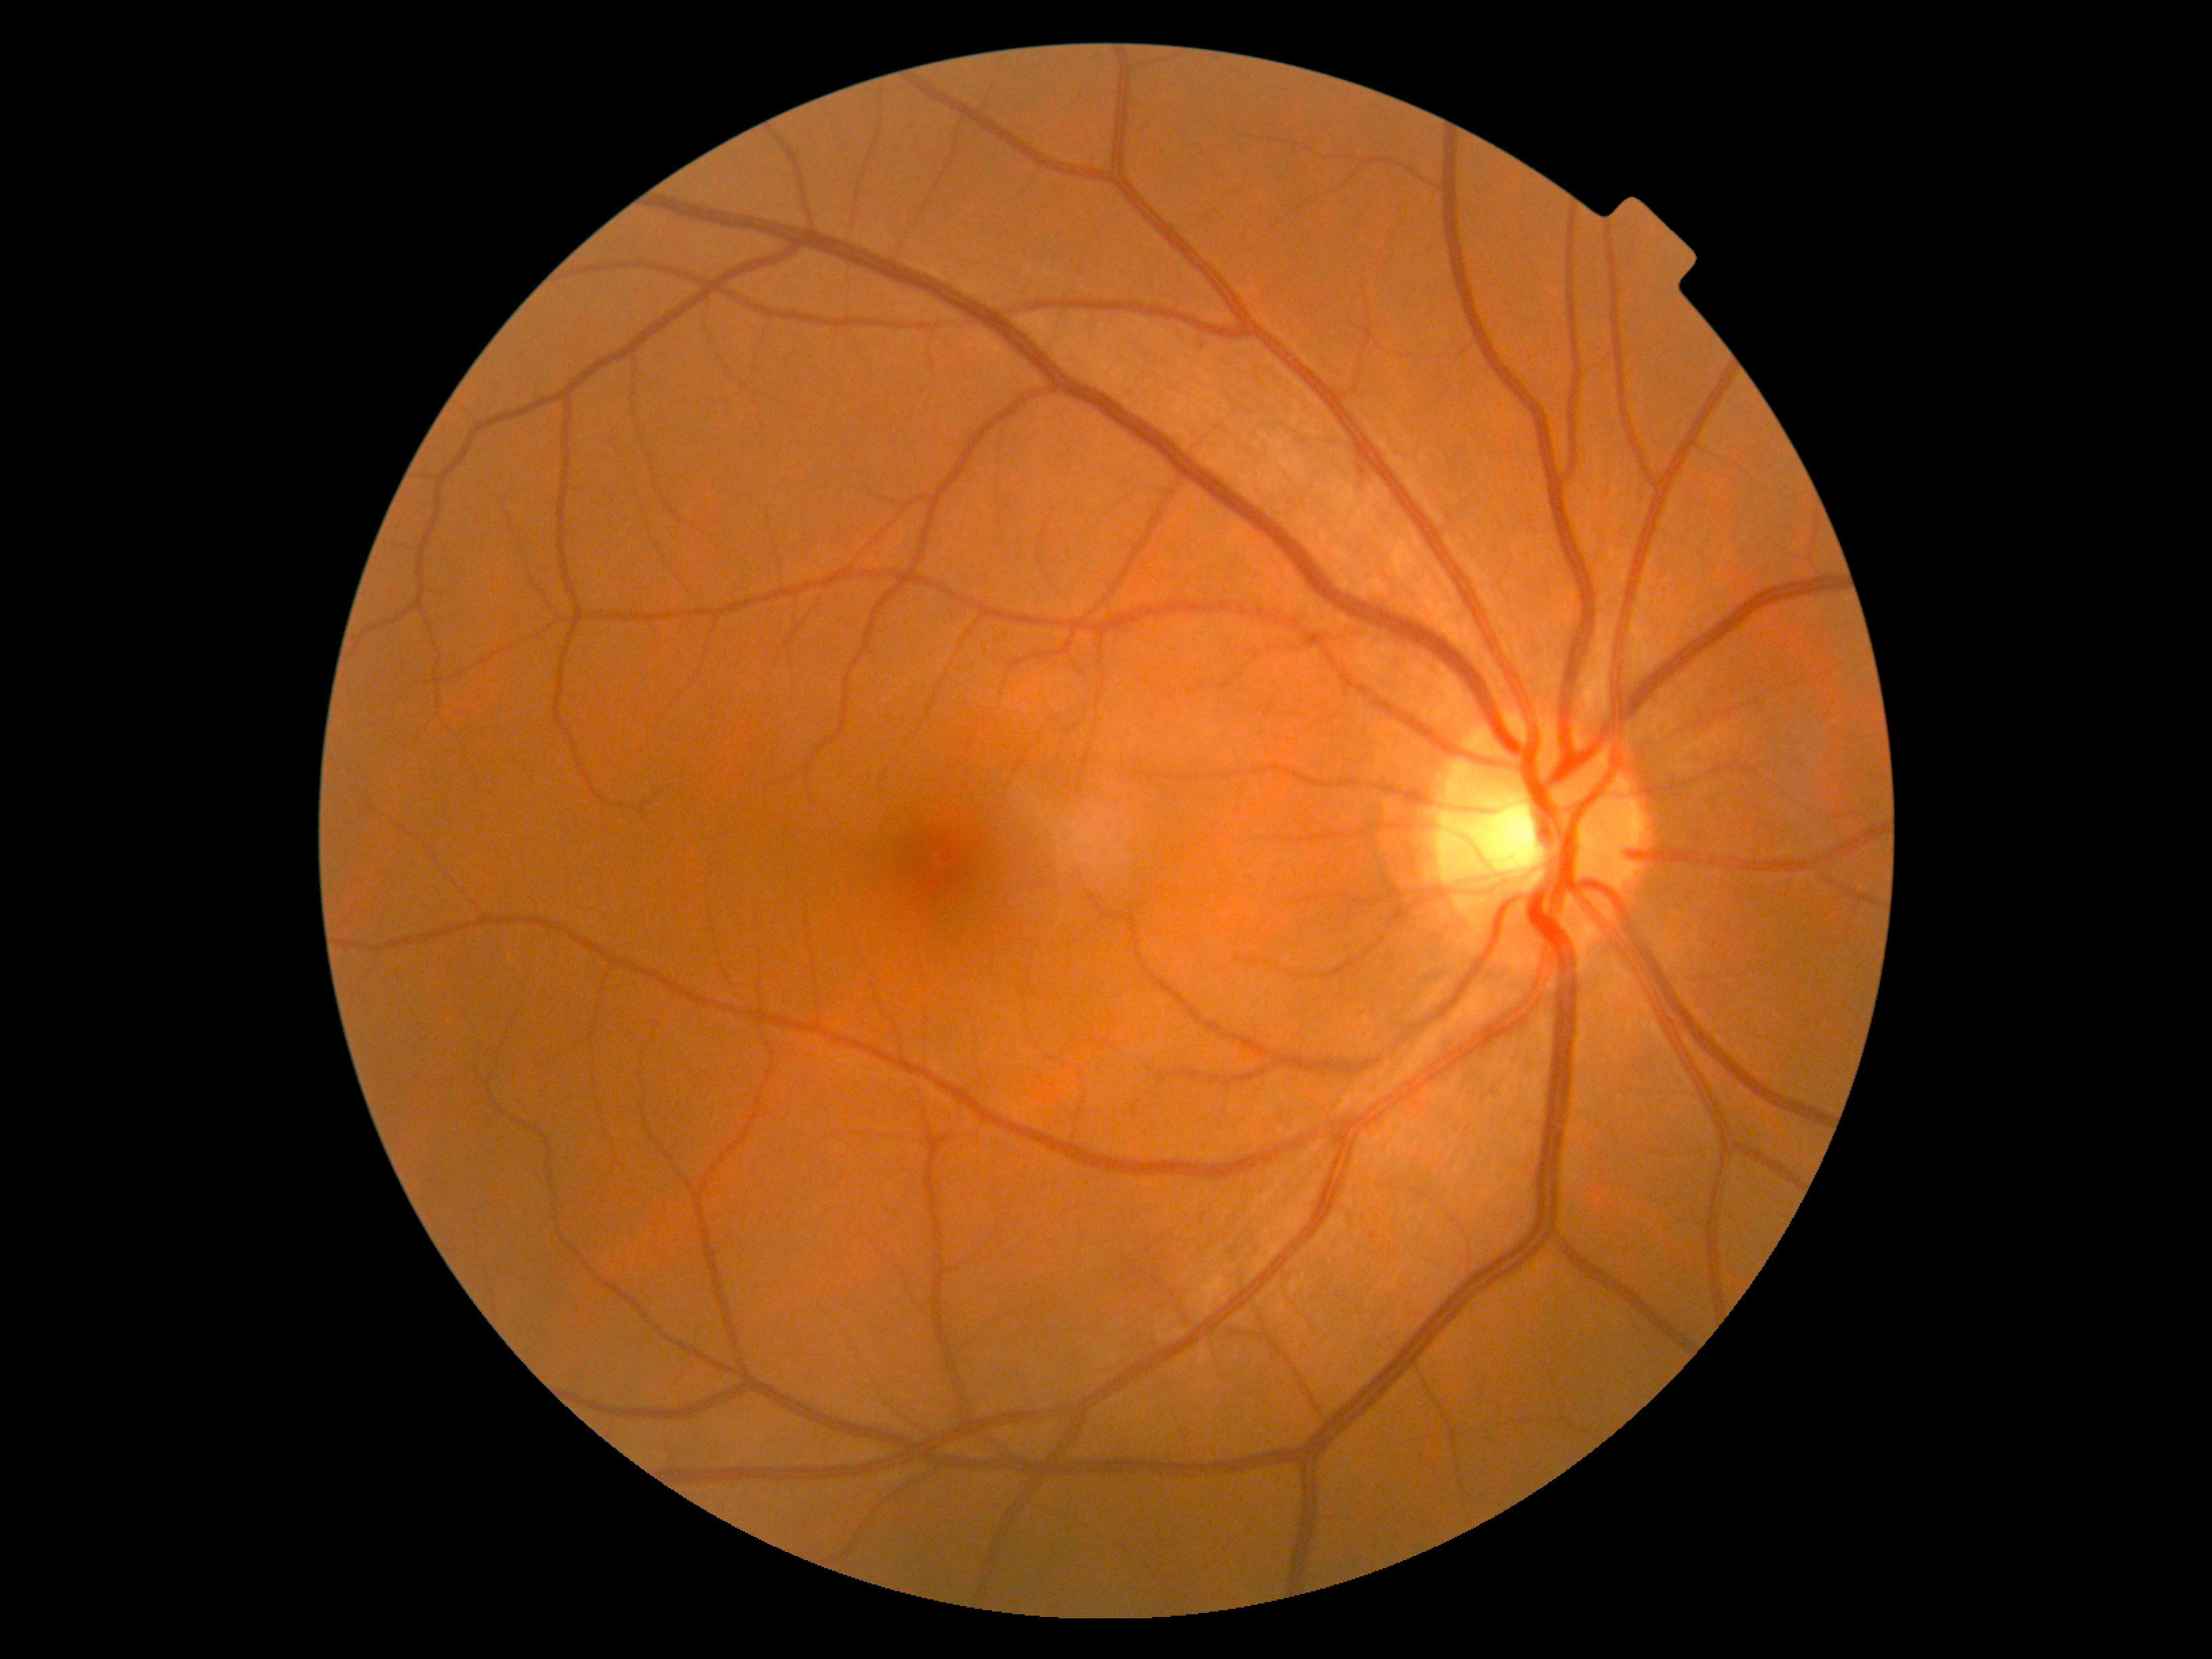
DR is 0/4.
No diabetic retinal disease findings.